Infant wide-field fundus photograph.
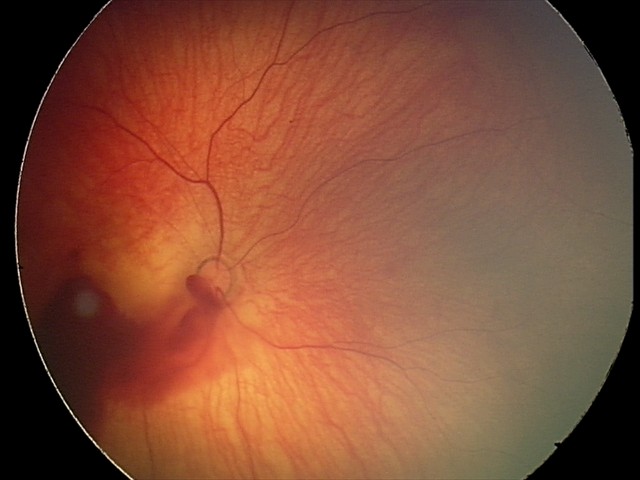
From an examination with diagnosis of retinal hemorrhages.